Fundus photo:
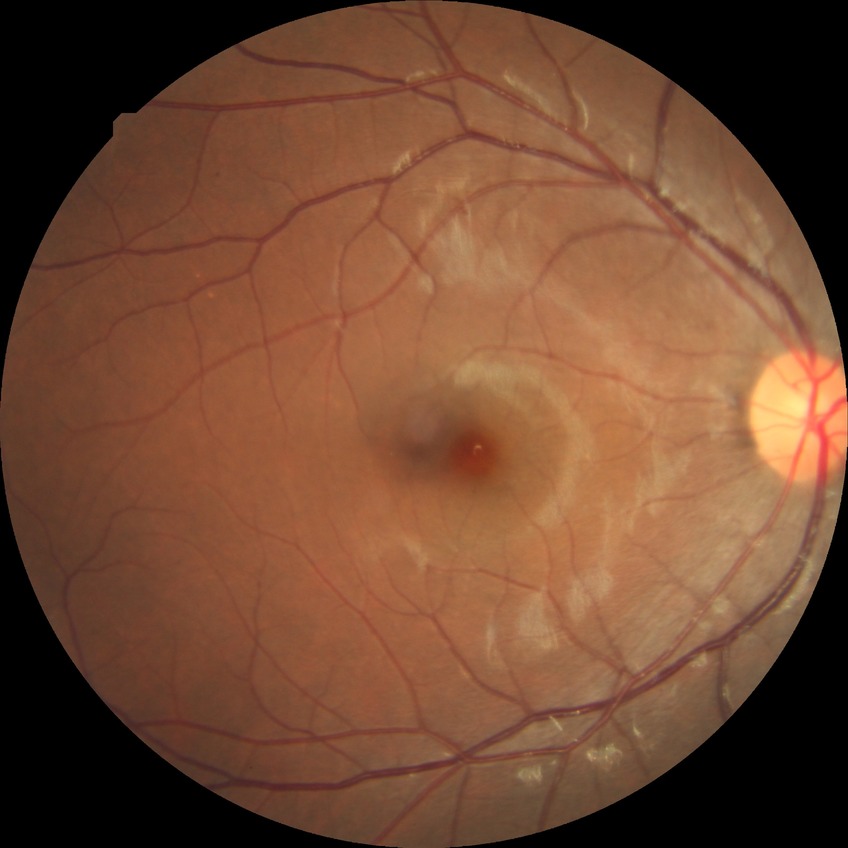
Davis grading: simple diabetic retinopathy.